Color fundus image
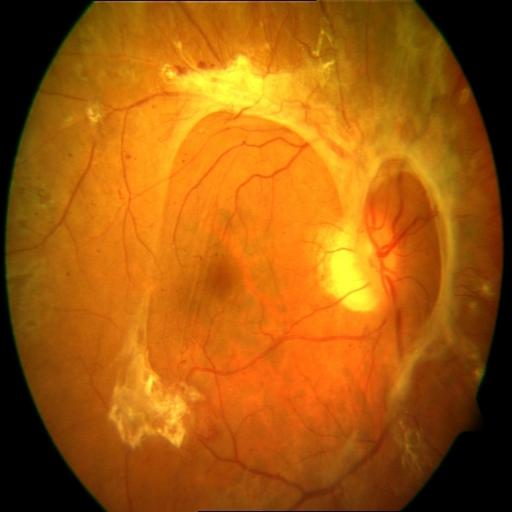
Diagnosis: retinal traction (RT); hemorrhagic retinopathy (HR).